2352 x 1568 pixels · 45-degree field of view.
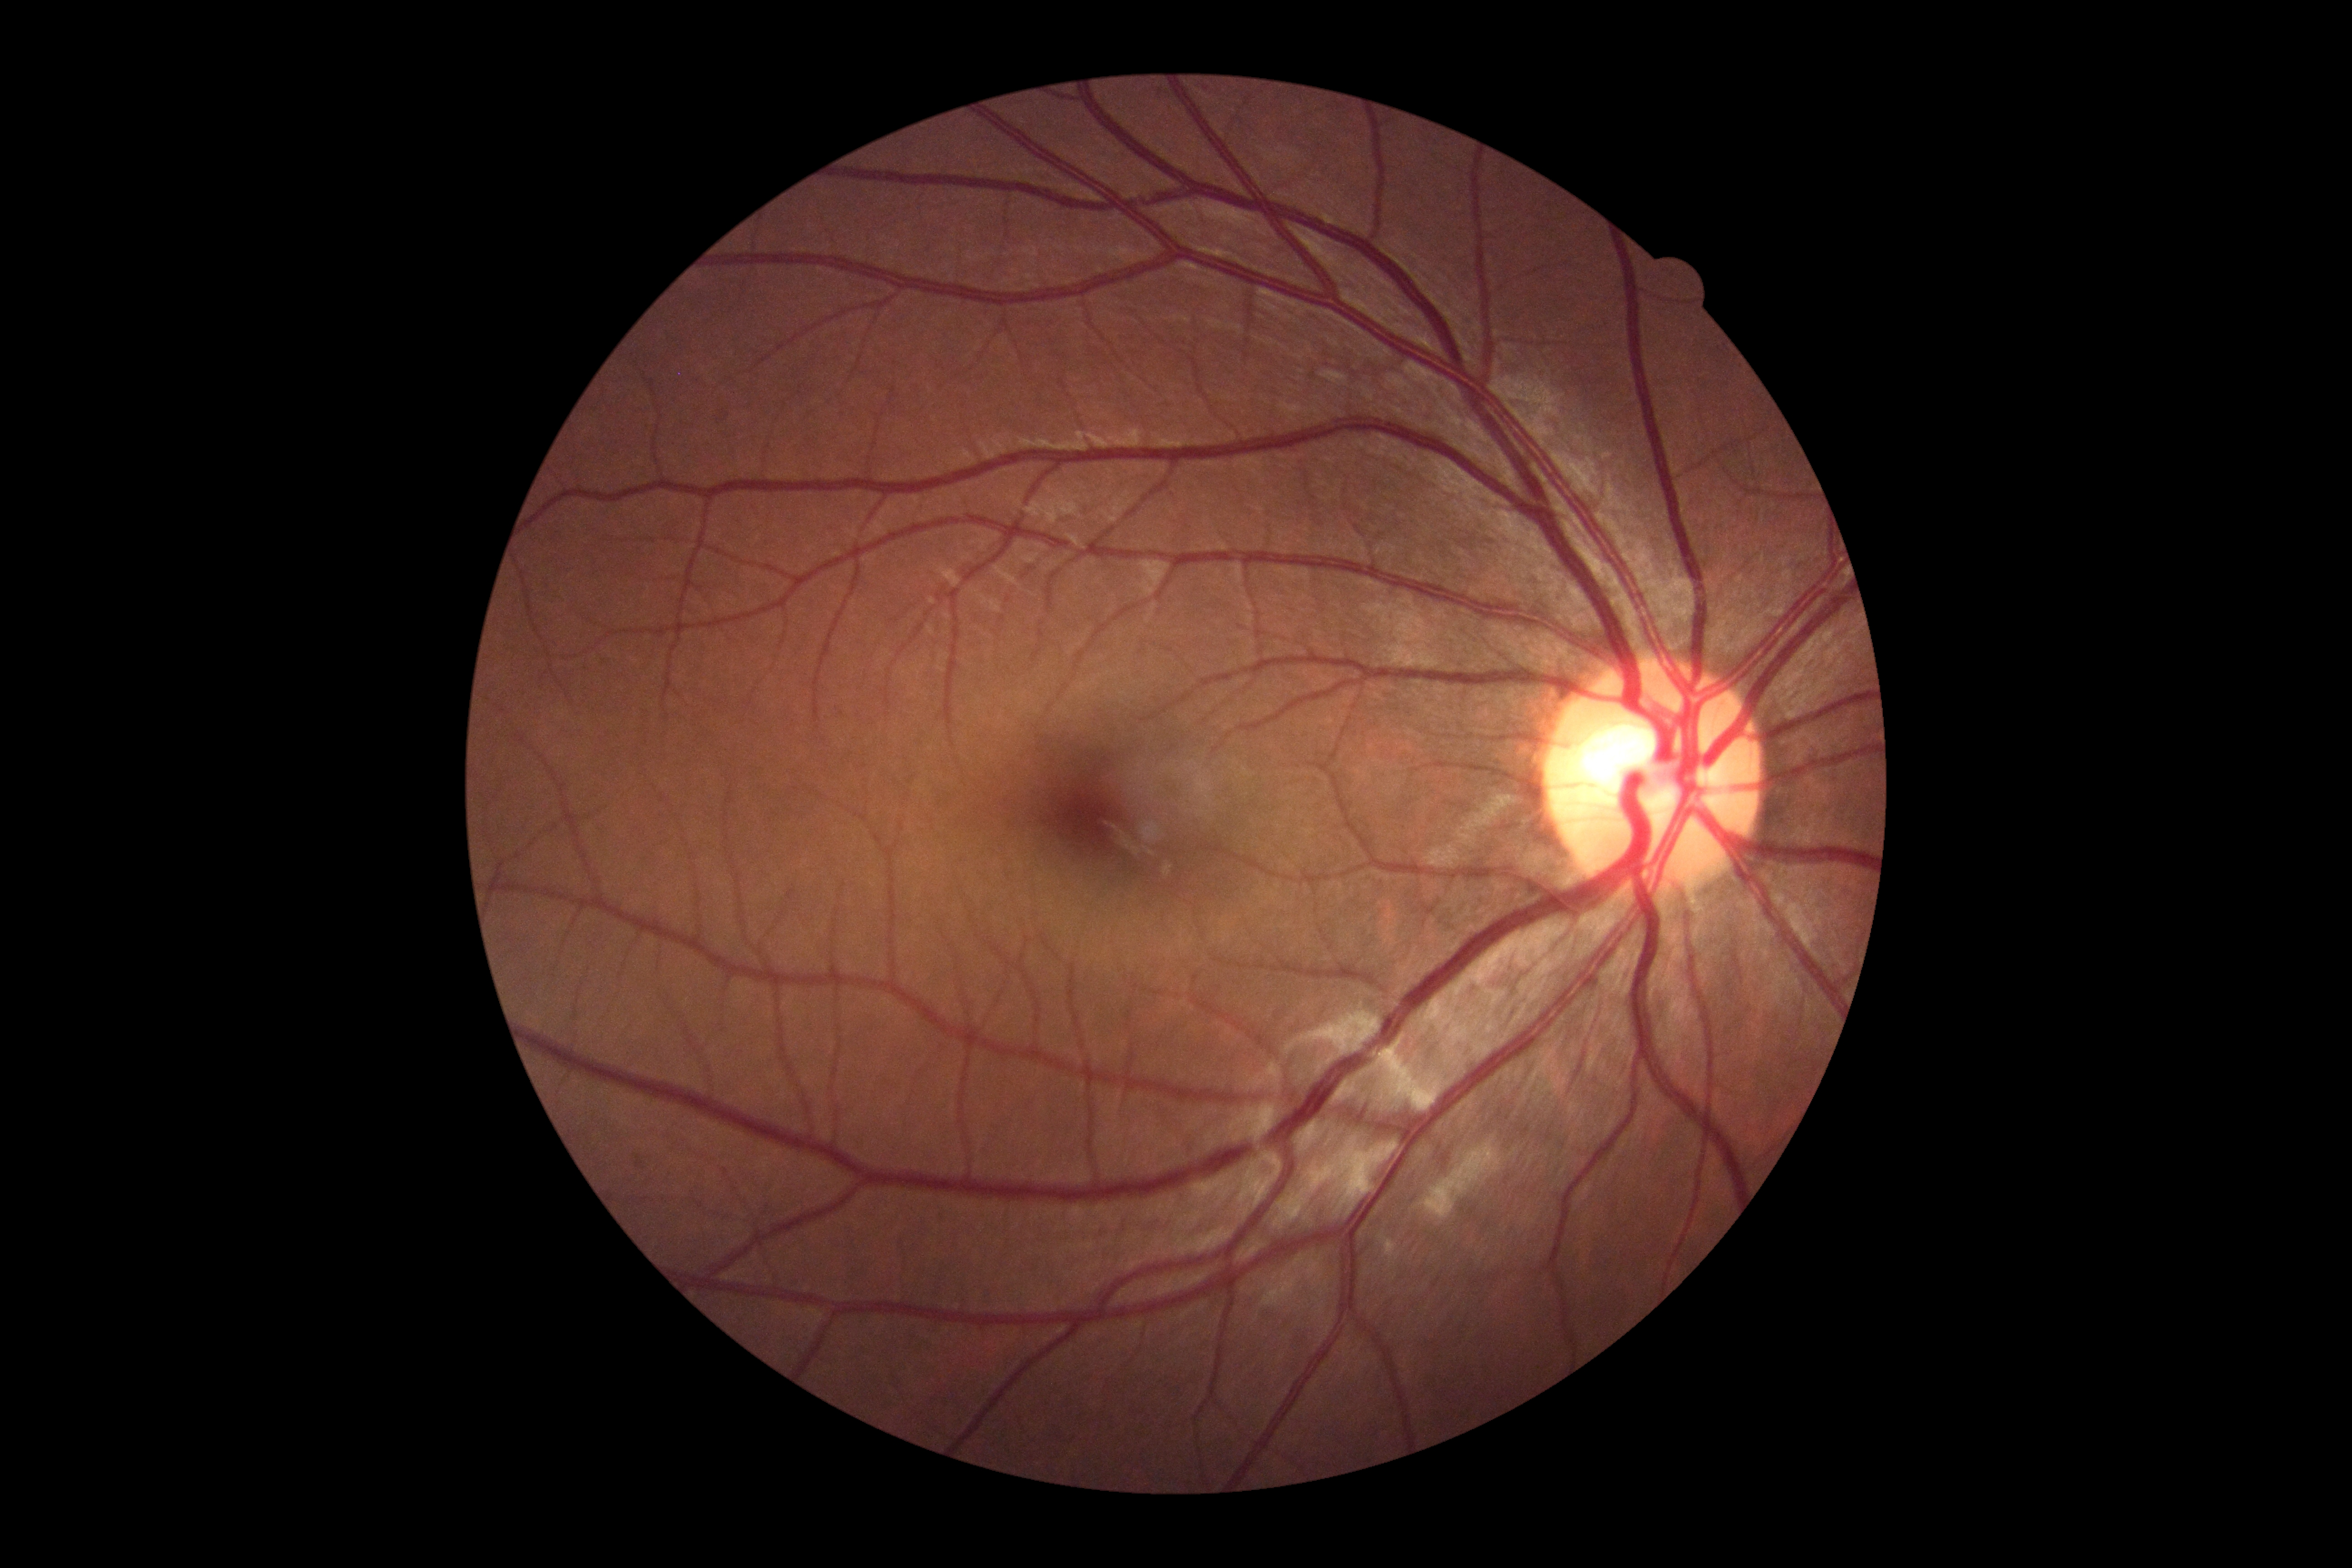 diabetic retinopathy (DR)@0.